NIDEK AFC-230, diabetic retinopathy graded by the modified Davis classification, without pupil dilation
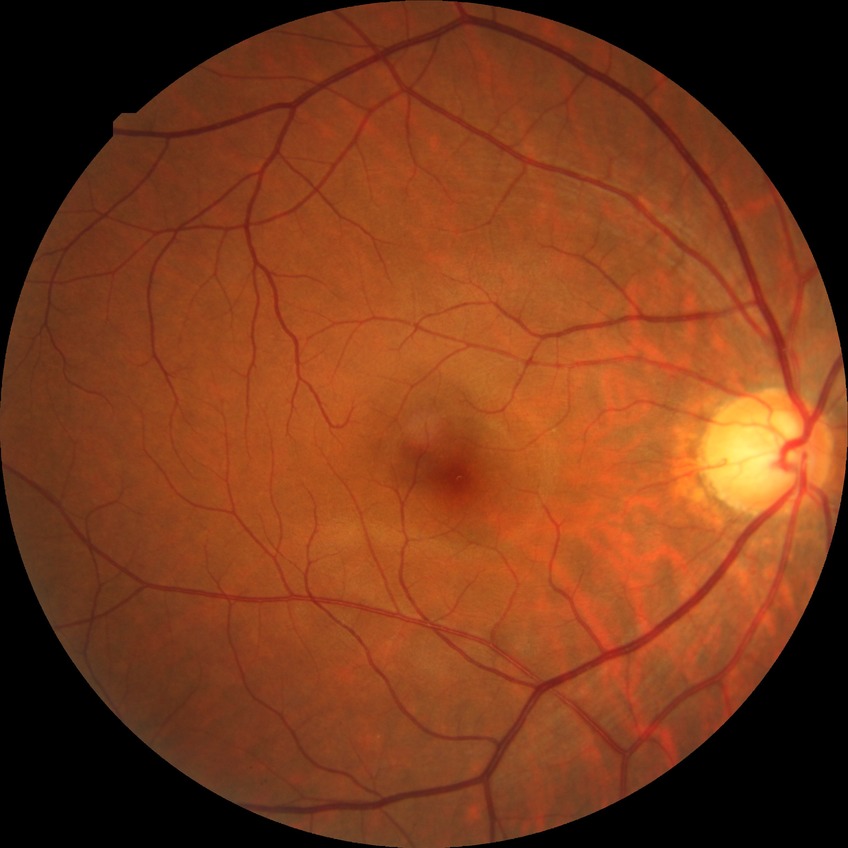
No signs of diabetic retinopathy.
Davis DR grade: NDR.